848x848, FOV: 45 degrees, posterior pole photograph, graded on the modified Davis scale, nonmydriatic fundus photograph, NIDEK AFC-230 fundus camera:
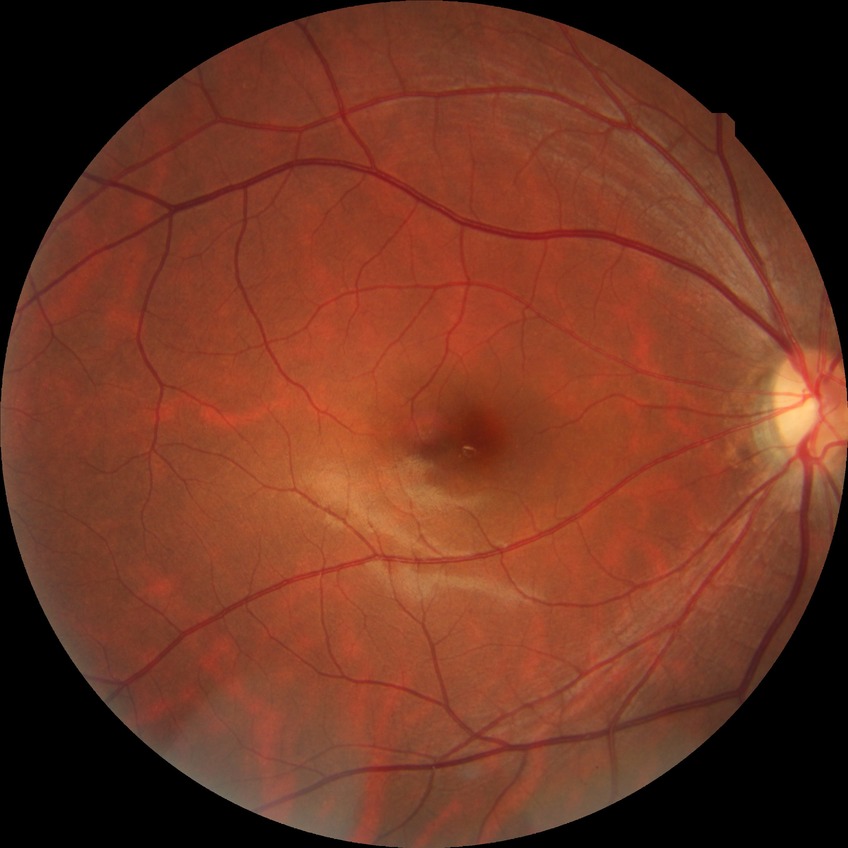

Diabetic retinopathy (DR) is no diabetic retinopathy (NDR).